DR severity per modified Davis staging, color fundus photograph, 848x848px:
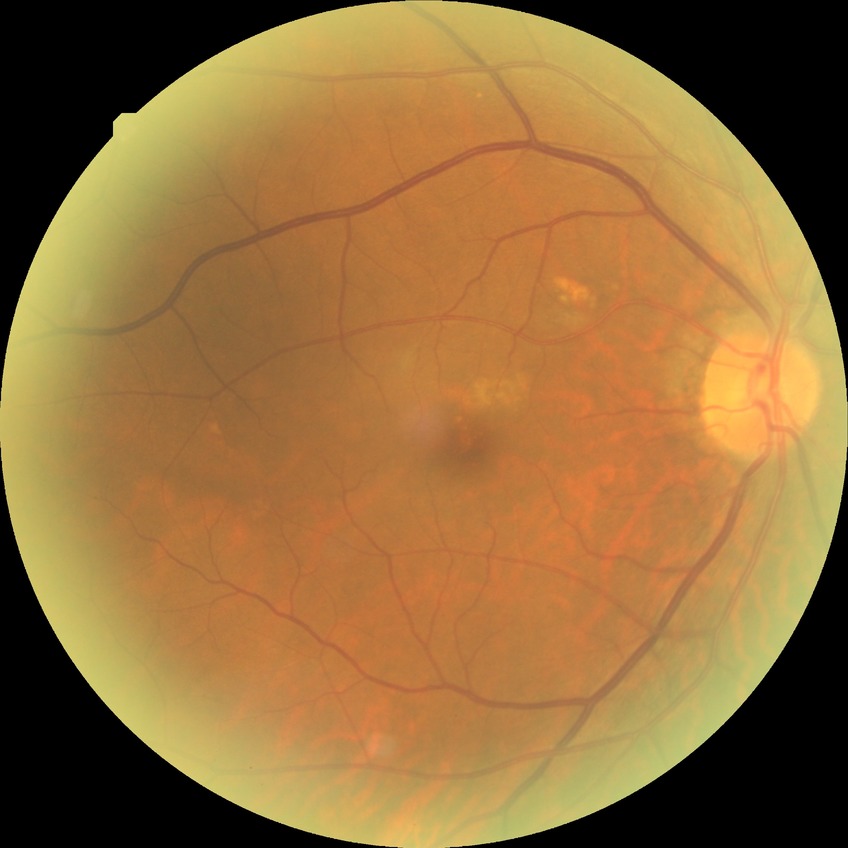 Diabetic retinopathy (DR) is no diabetic retinopathy (NDR).